Captured with the Natus RetCam Envision (130° field of view). Wide-field contact fundus photograph of an infant — 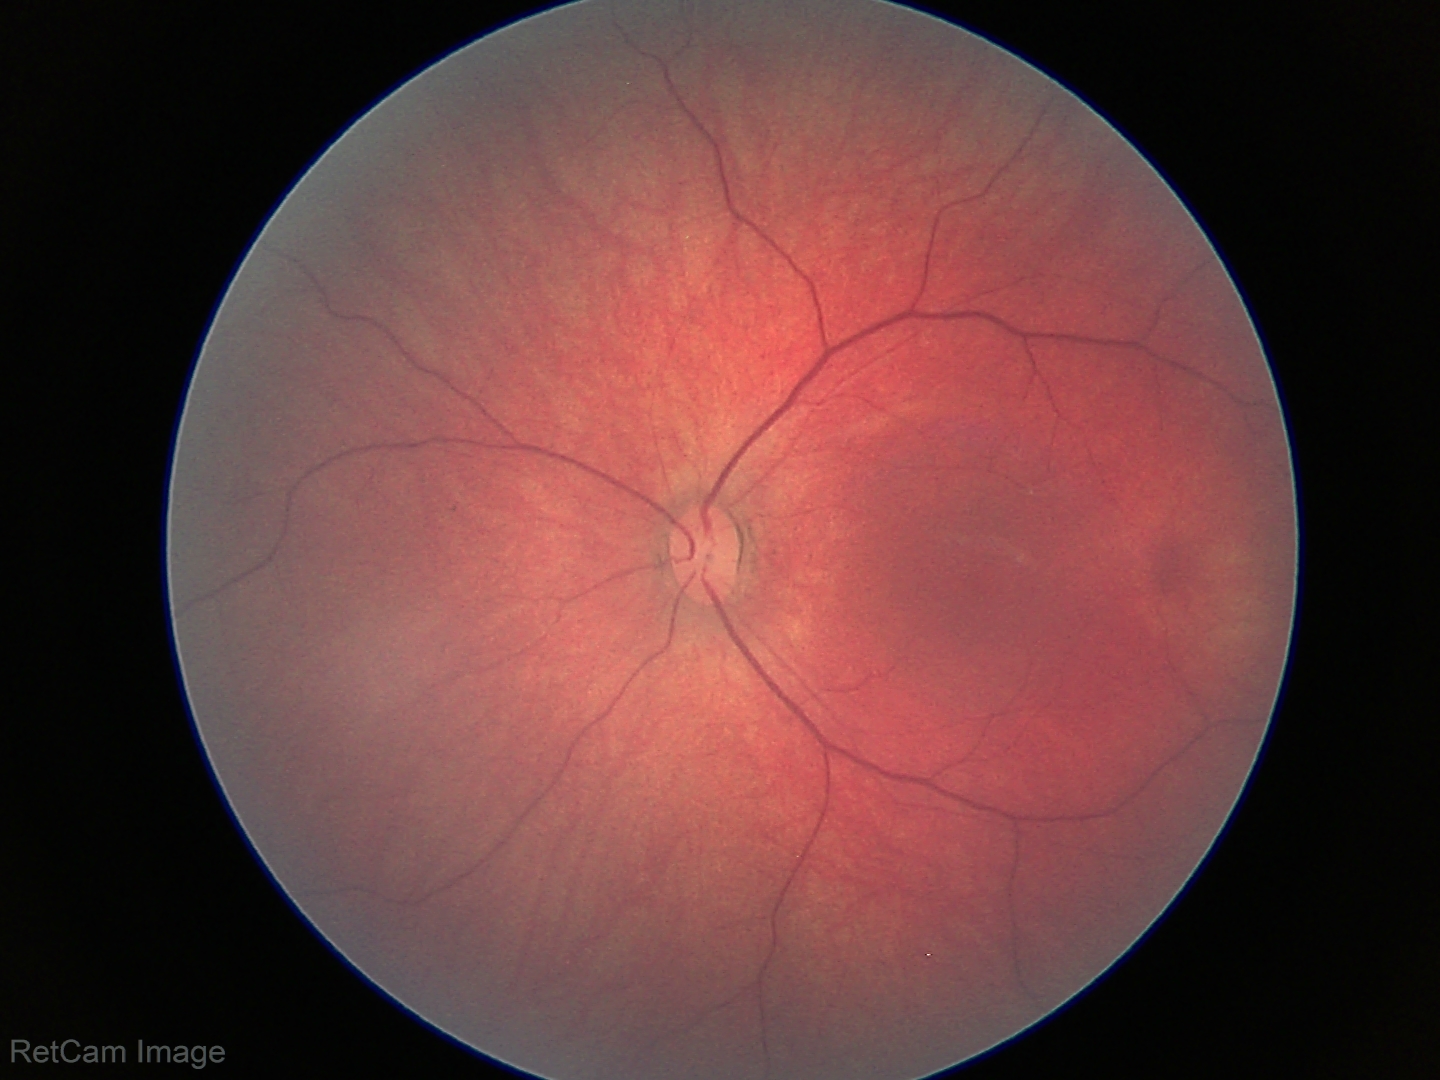

Examination with physiological retinal findings.